45° field of view:
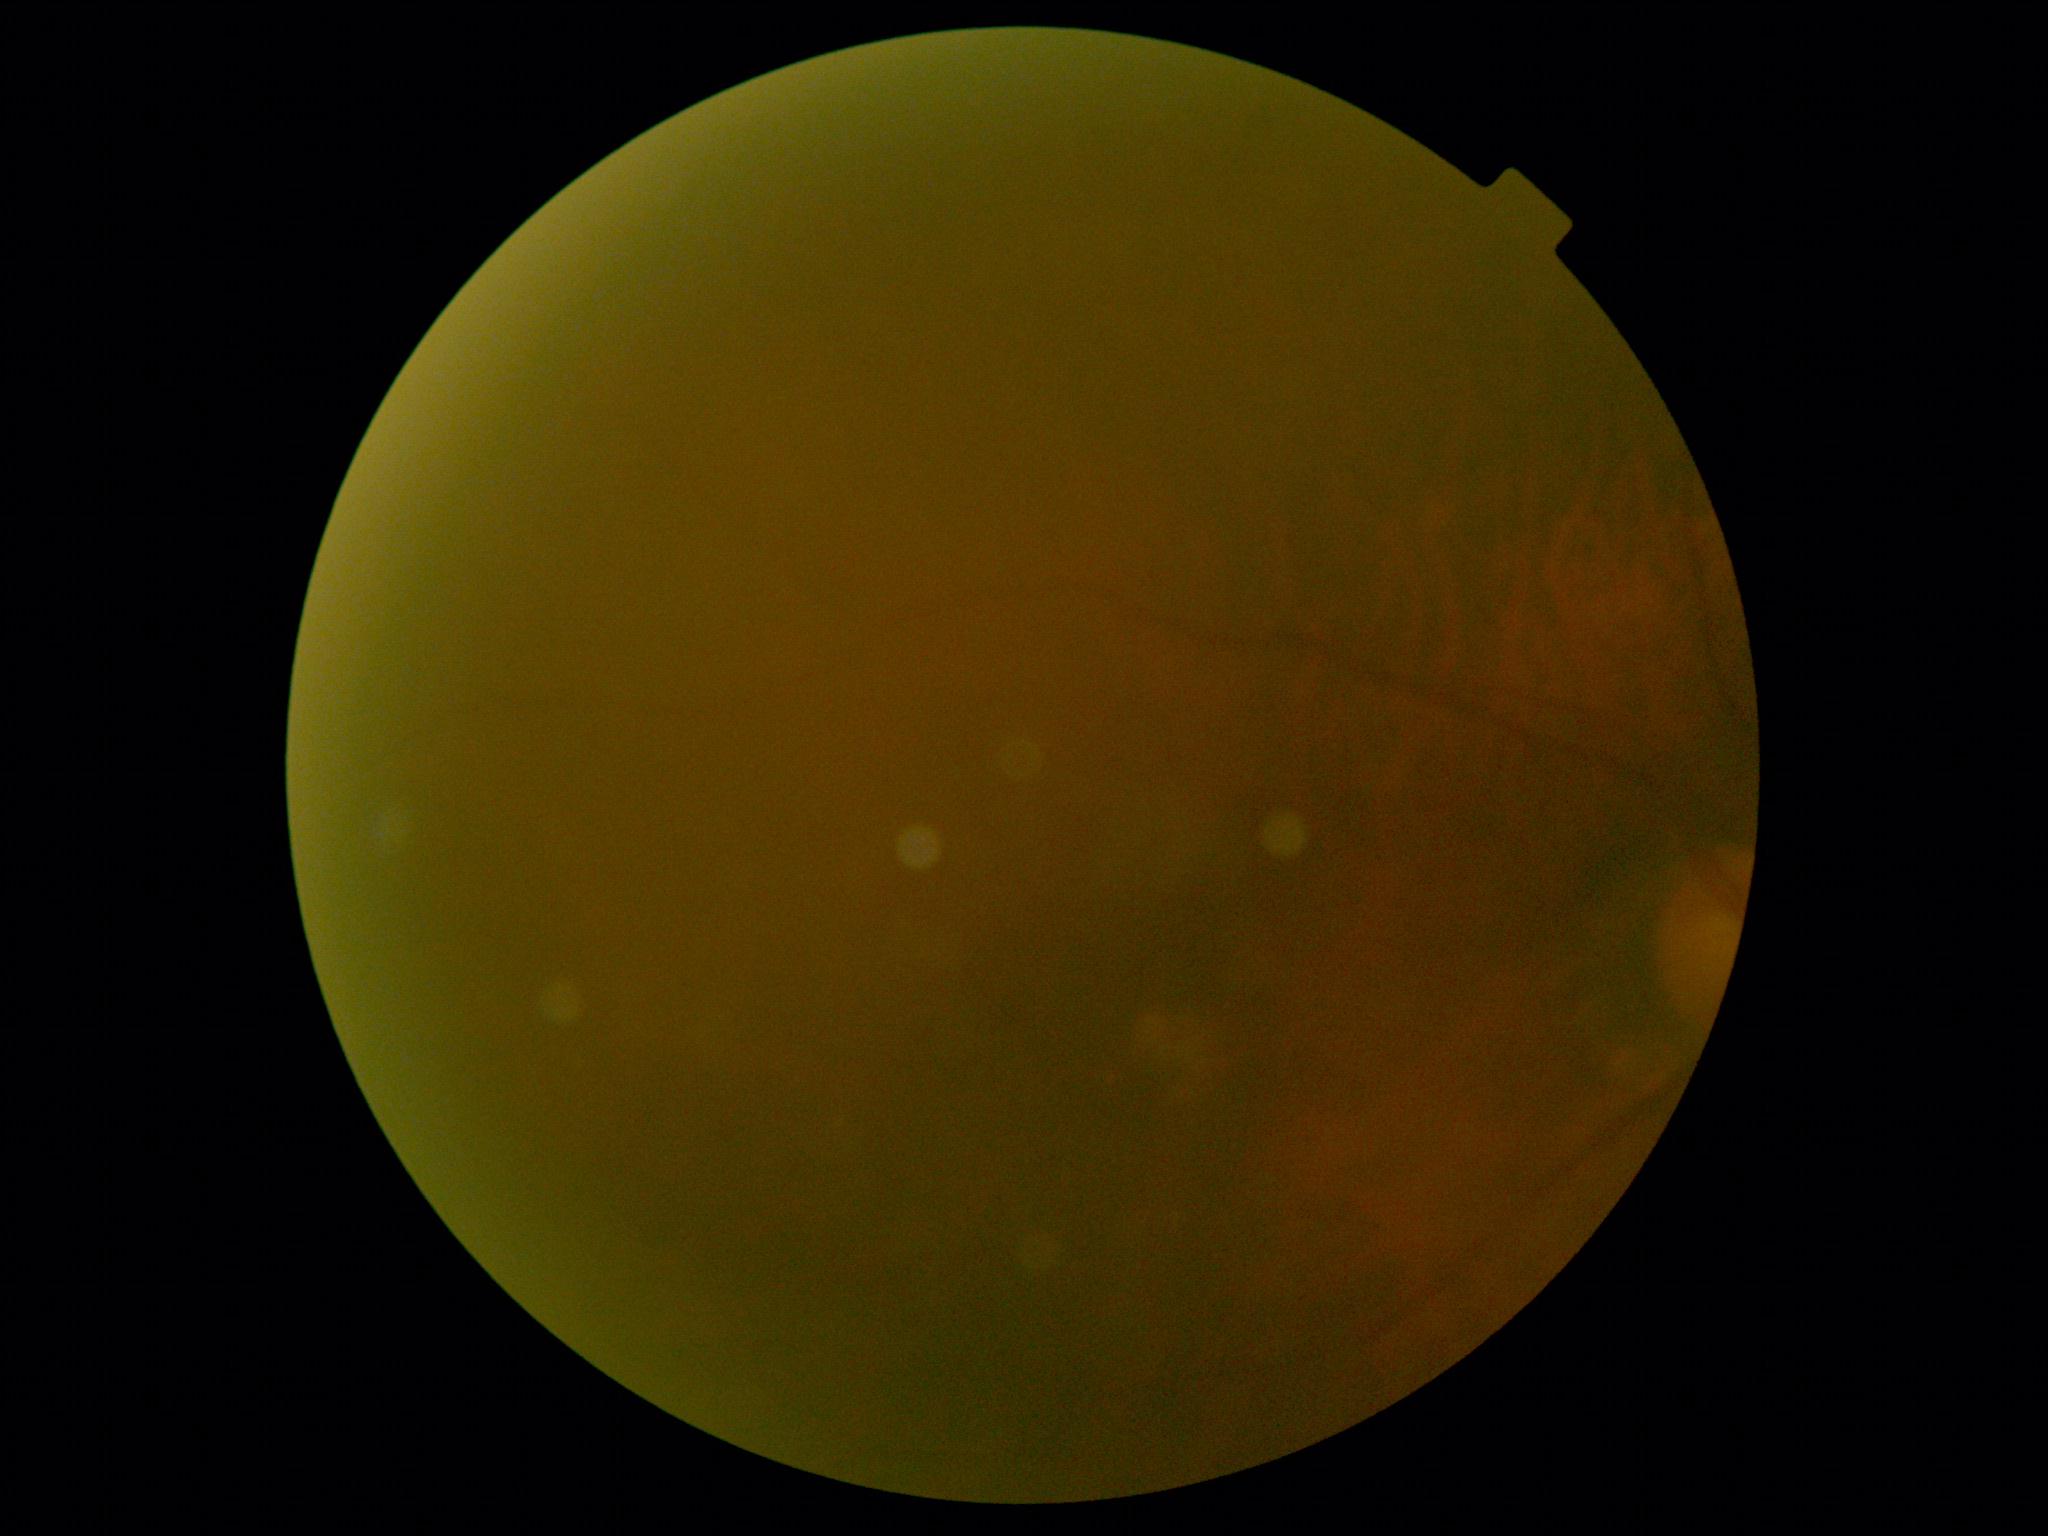
DR severity=ungradable due to poor image quality.